RetCam wide-field infant fundus image.
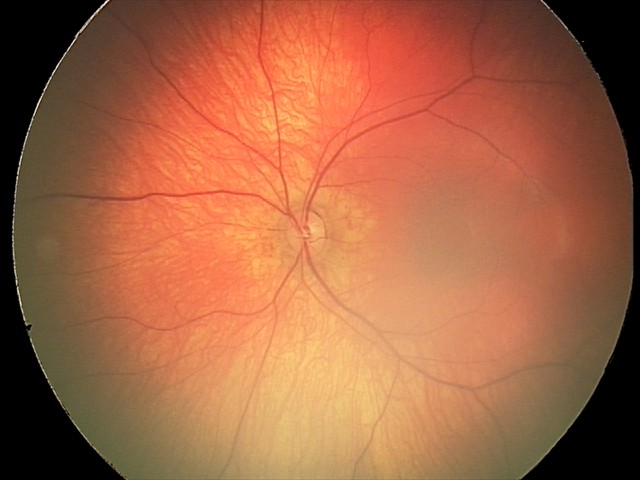
No retinal pathology identified on screening.